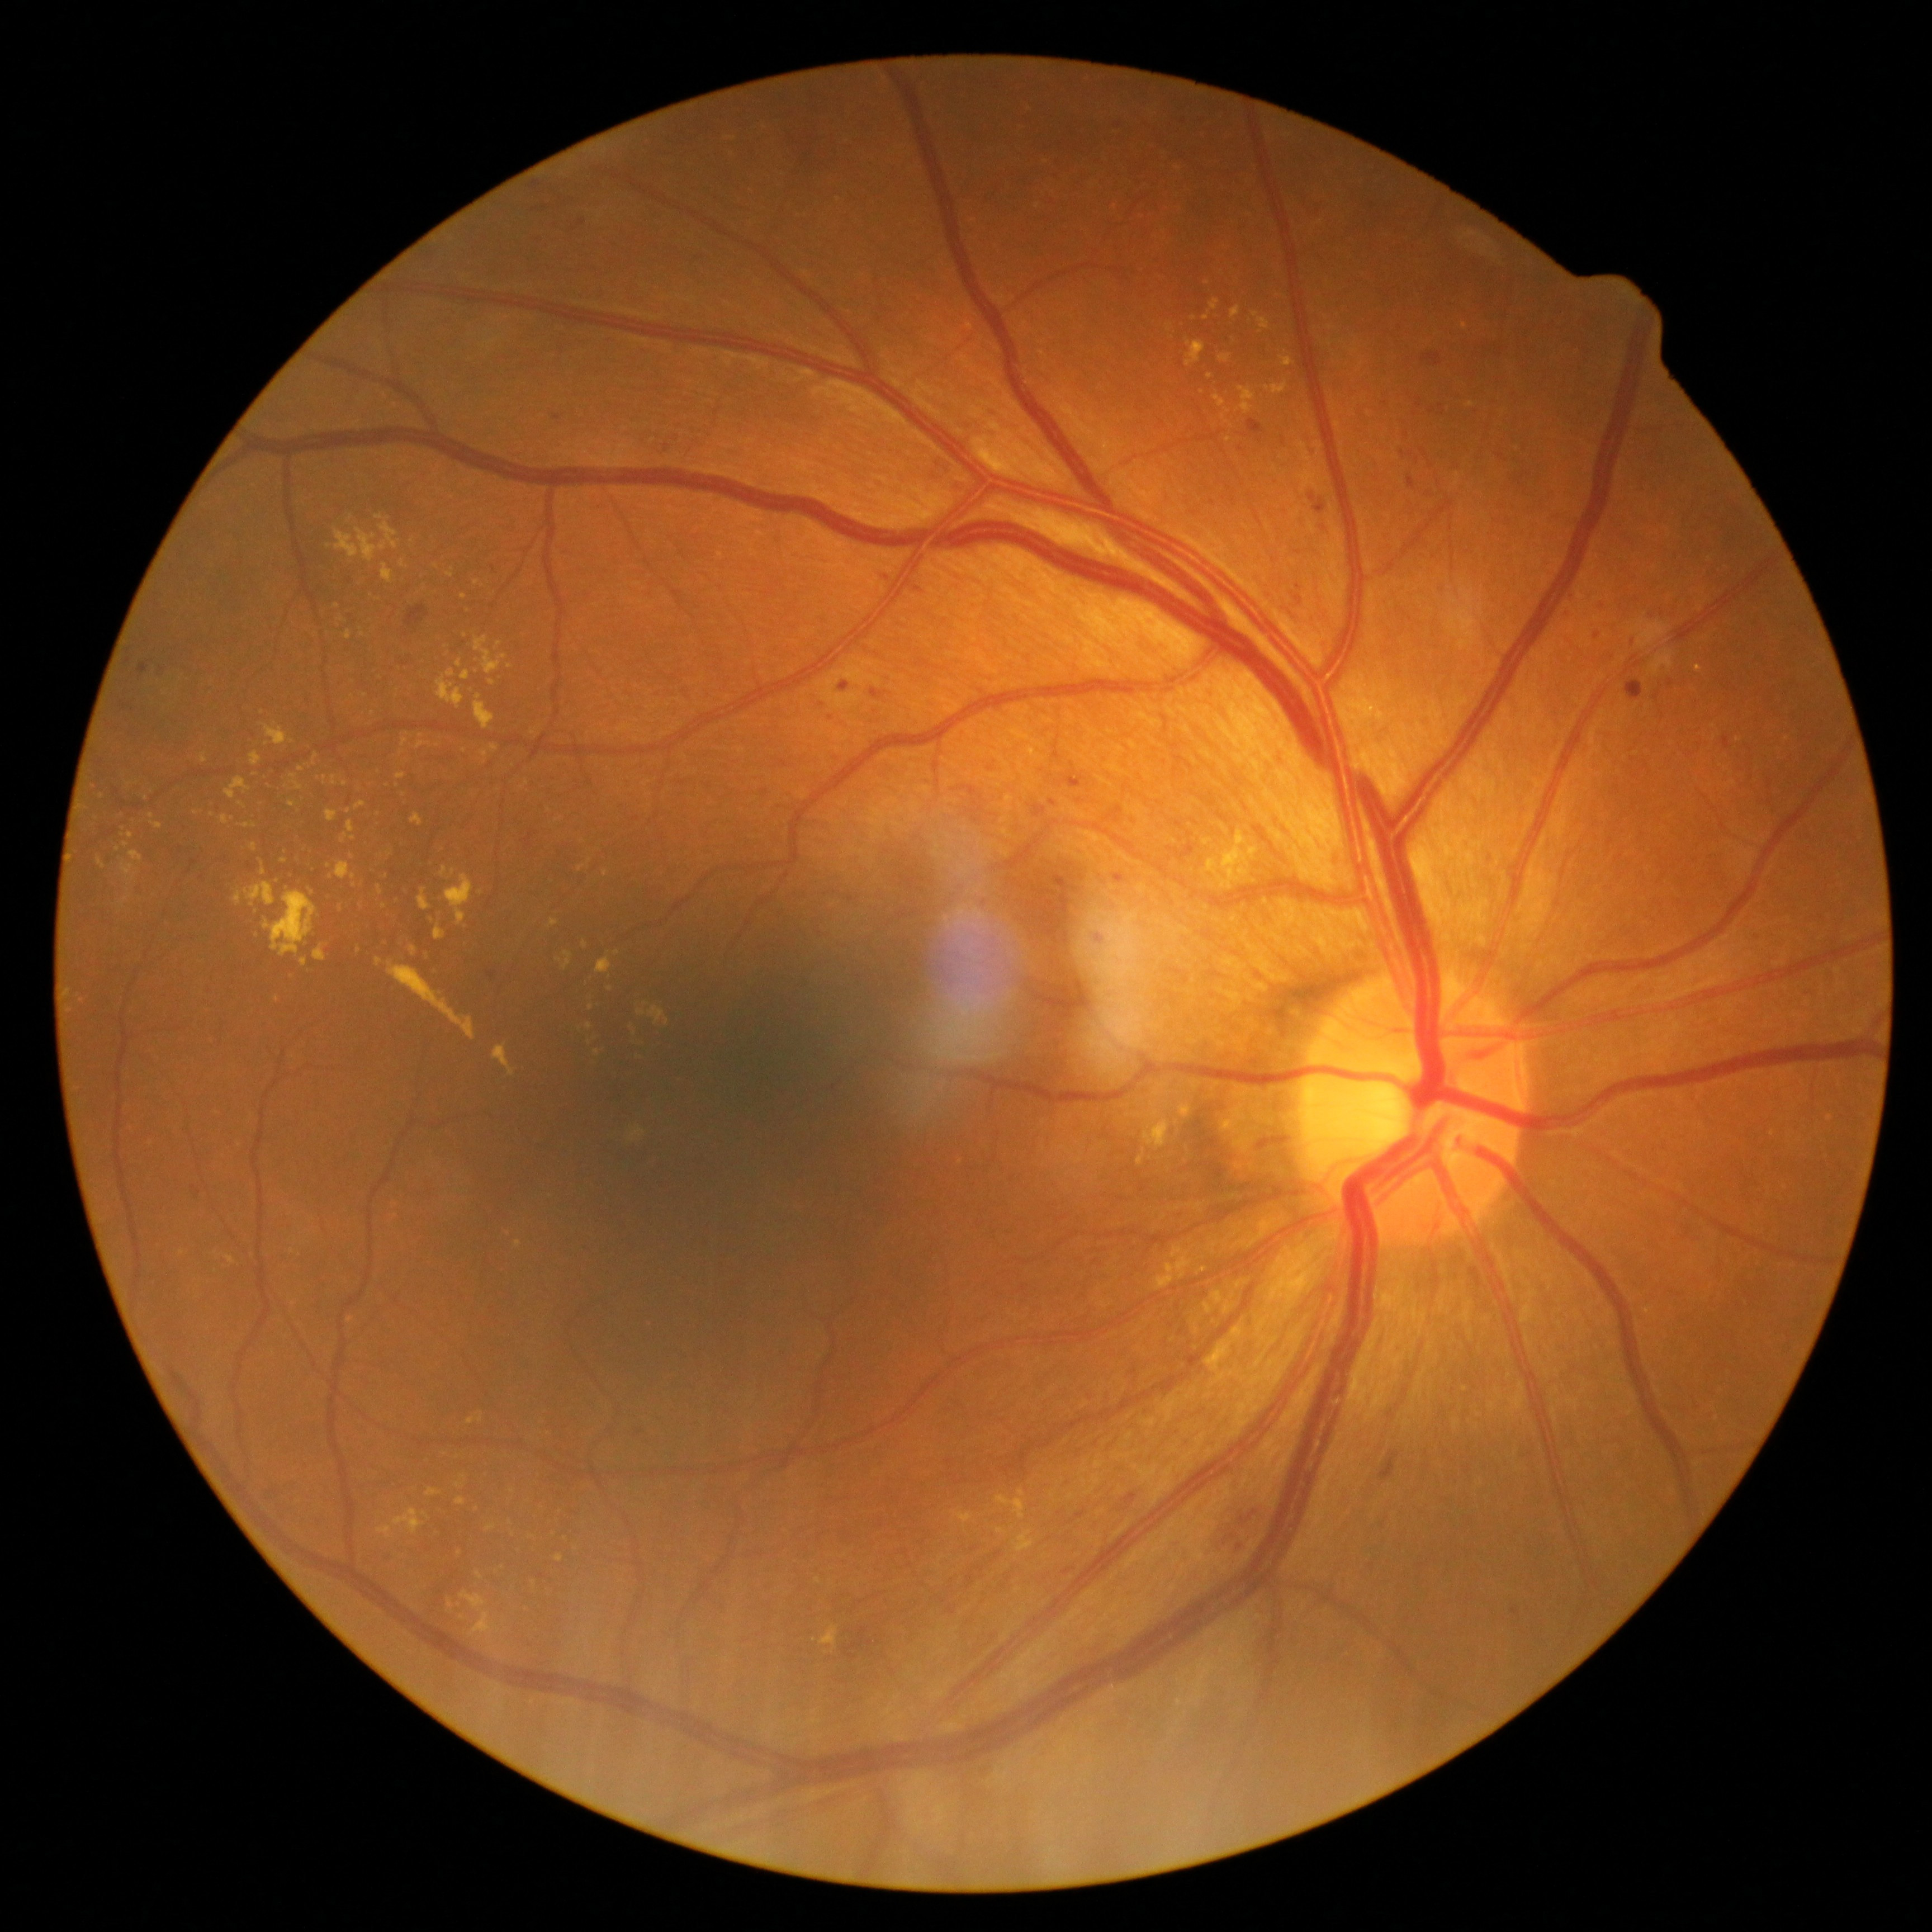

Diabetic retinopathy (DR): grade 2 (moderate NPDR)
A subset of detected lesions:
hard exudates (EXs) (partial): {"left": 1239, "top": 387, "right": 1255, "bottom": 414}; {"left": 427, "top": 1488, "right": 441, "bottom": 1497}; {"left": 359, "top": 630, "right": 365, "bottom": 638}; {"left": 595, "top": 958, "right": 612, "bottom": 973}; {"left": 222, "top": 816, "right": 231, "bottom": 825}; {"left": 1218, "top": 831, "right": 1257, "bottom": 889}; {"left": 314, "top": 945, "right": 326, "bottom": 961}; {"left": 637, "top": 1010, "right": 646, "bottom": 1017}; {"left": 347, "top": 821, "right": 355, "bottom": 834}; {"left": 244, "top": 882, "right": 276, "bottom": 907}; {"left": 1018, "top": 1490, "right": 1026, "bottom": 1497}; {"left": 410, "top": 946, "right": 418, "bottom": 955}
EXs (small, approximate centers) near pt(463, 597); pt(588, 1653); pt(605, 874); pt(589, 1026); pt(510, 491); pt(580, 869); pt(1223, 417); pt(481, 893)